Disc-centered field.
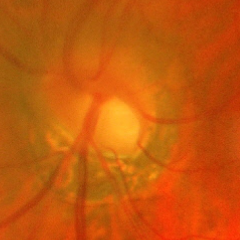 Glaucoma diagnosis = advanced-stage glaucoma.